Color fundus image — 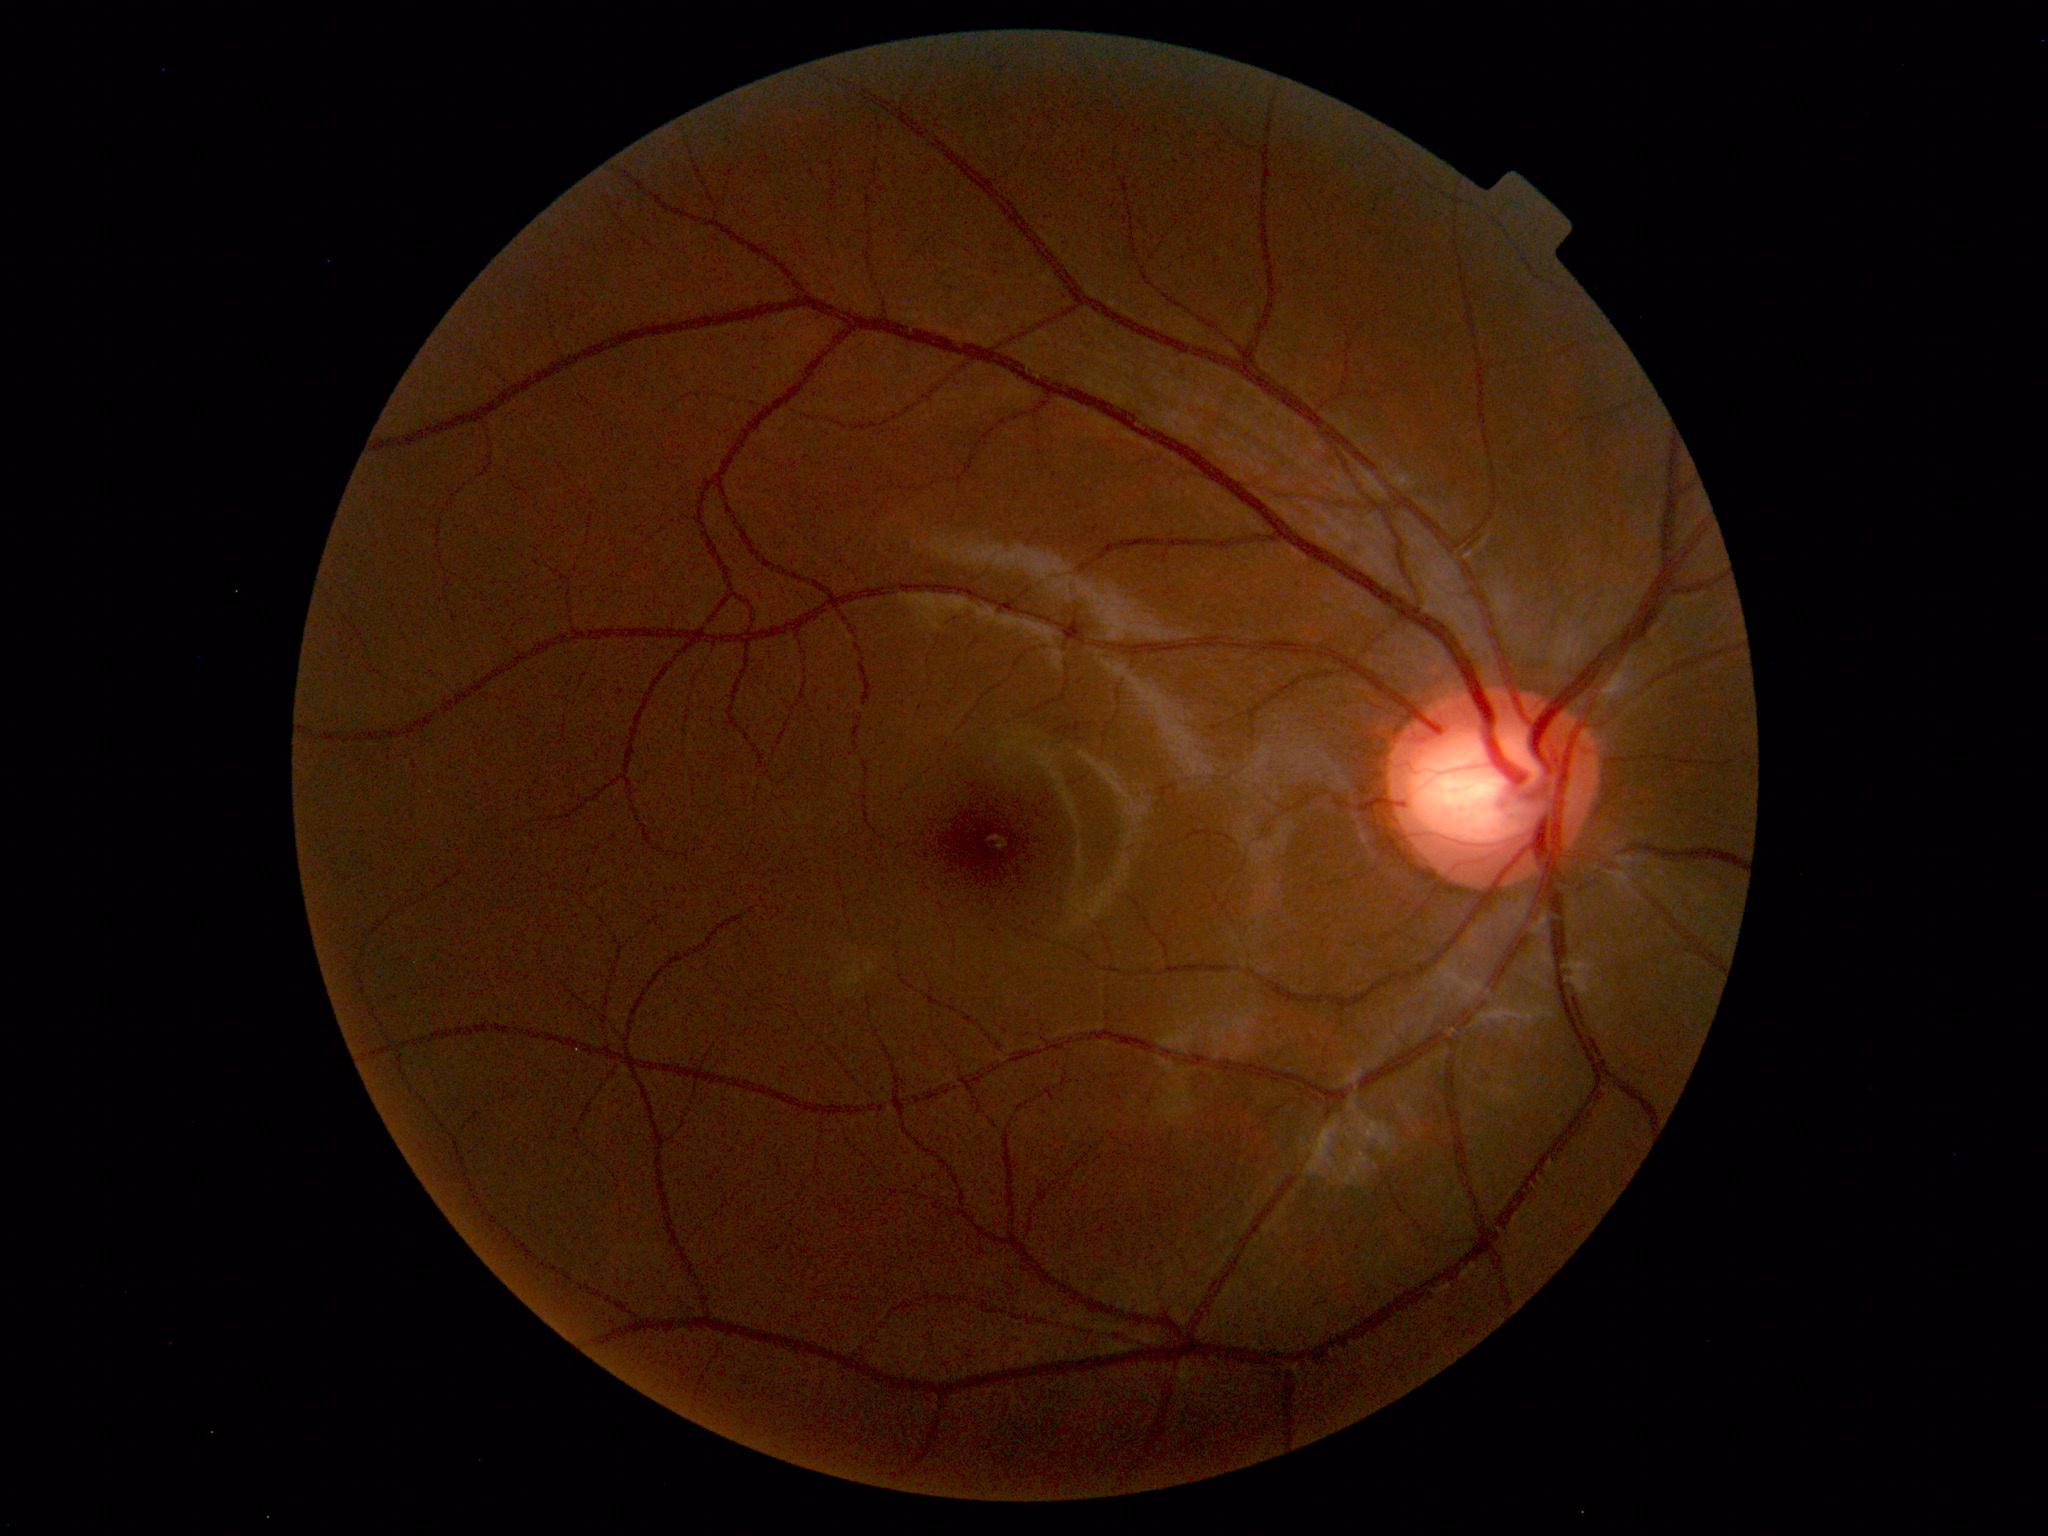 Normal fundus. No pathology identified.